45 degree fundus photograph. Nonmydriatic fundus photograph. Acquired with a NIDEK AFC-230. 848x848px. CFP
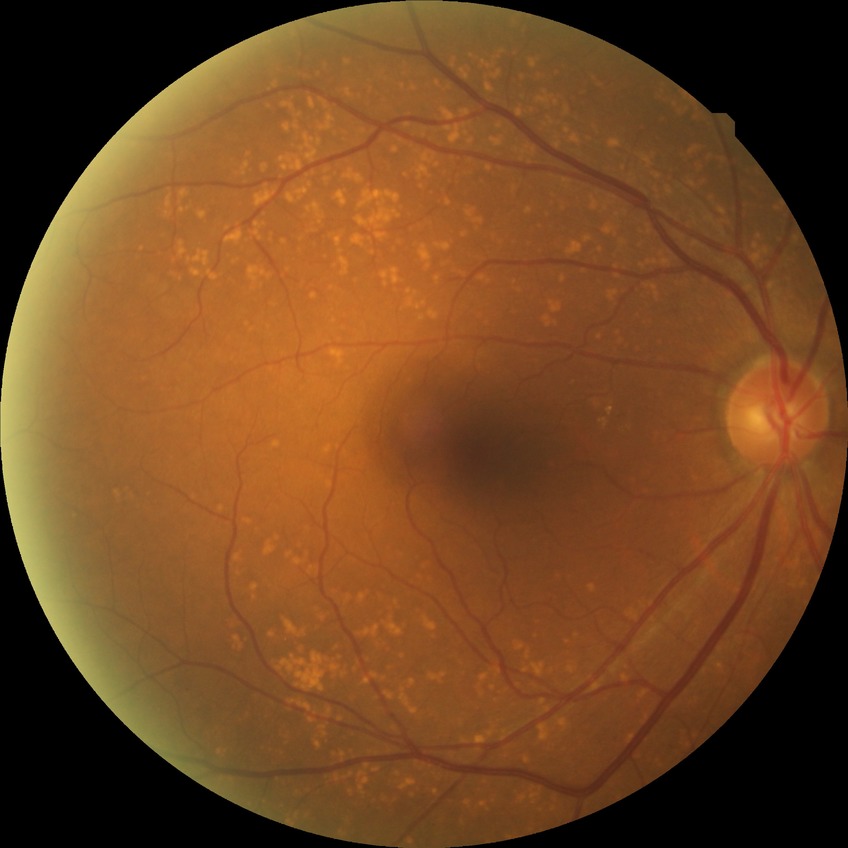 diabetic retinopathy (DR): no diabetic retinopathy (NDR).